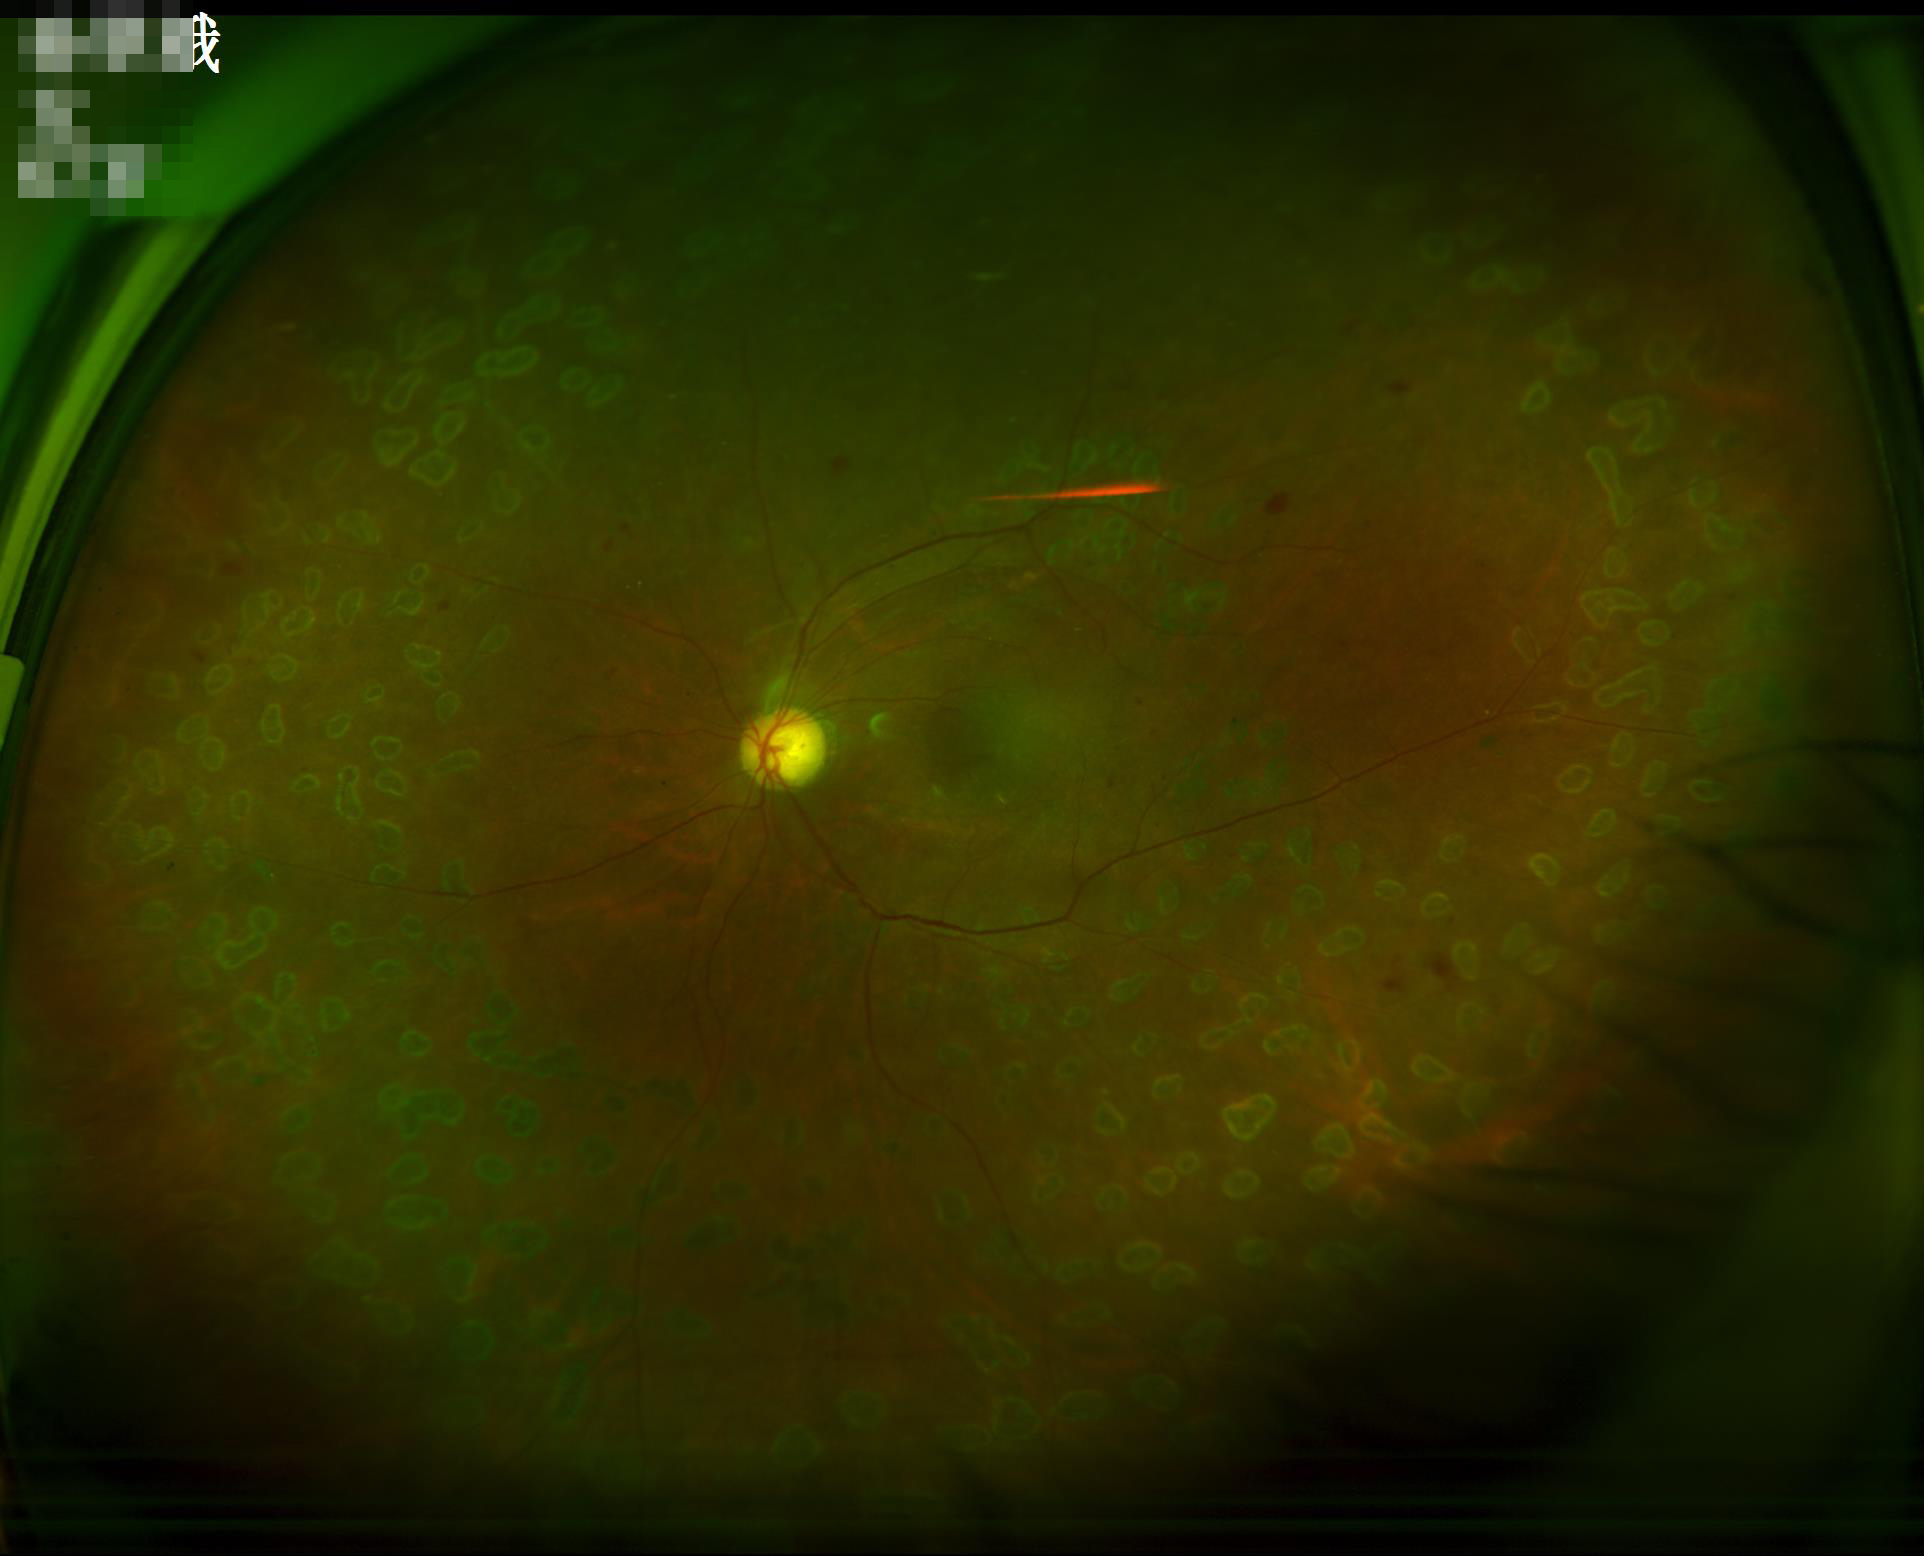

Good dynamic range. Acceptable image quality. Even illumination with no color cast. Image is sharp throughout the field.